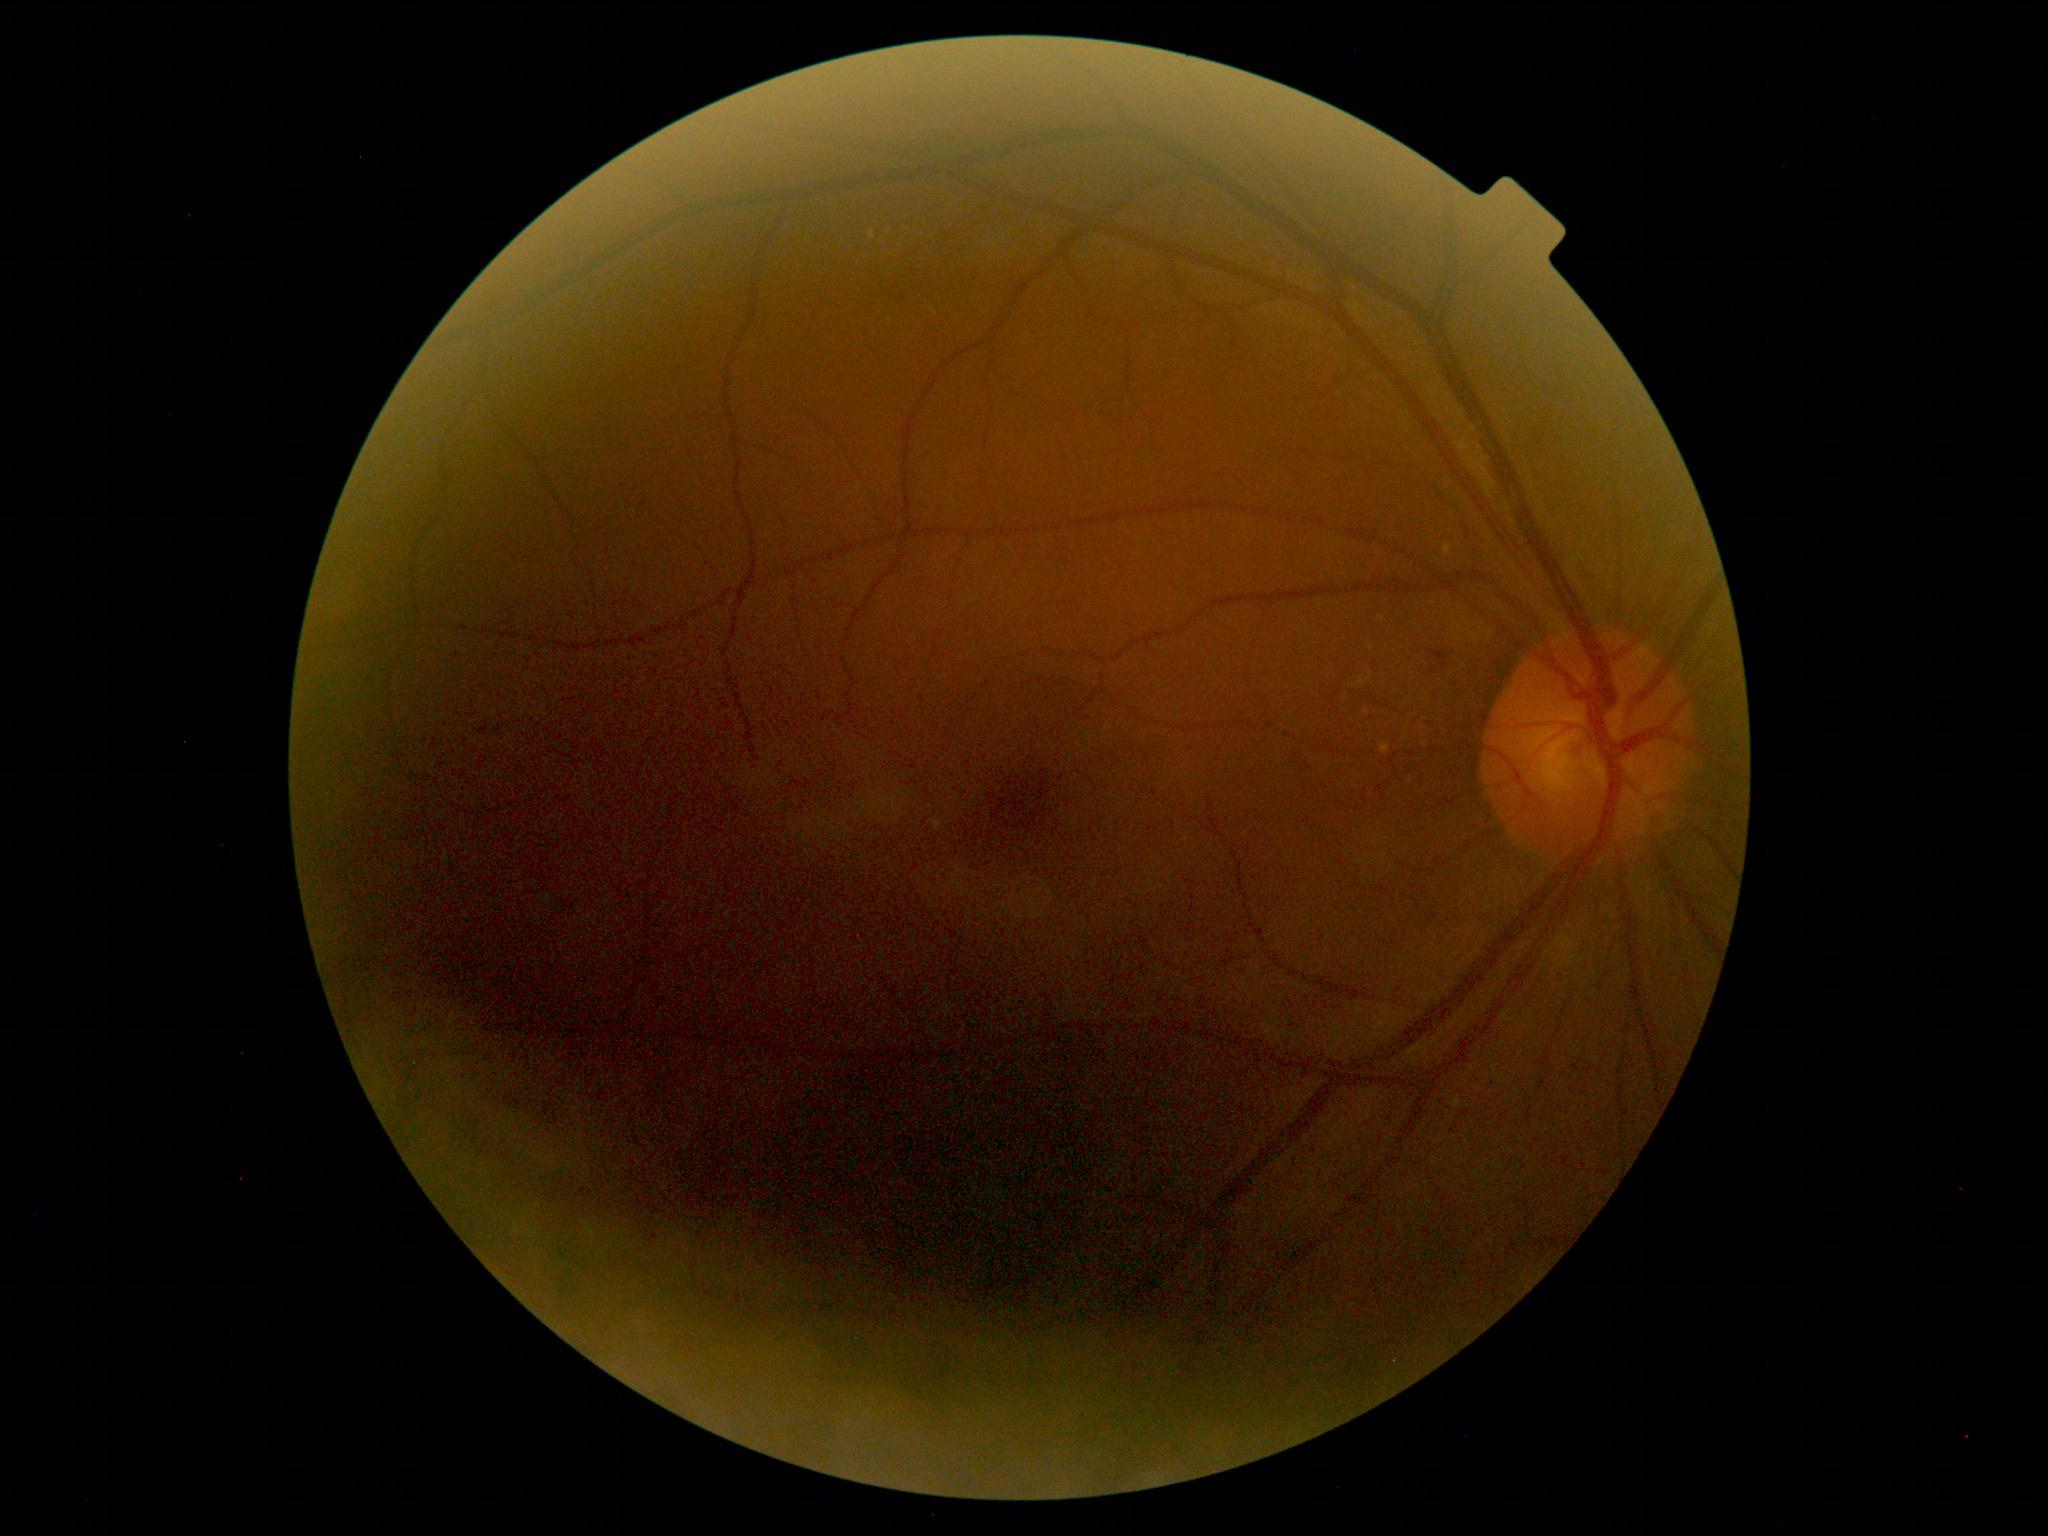
DR severity is 2/4 — more than just microaneurysms but less than severe NPDR.